Pediatric wide-field fundus photograph. 1440 x 1080 pixels
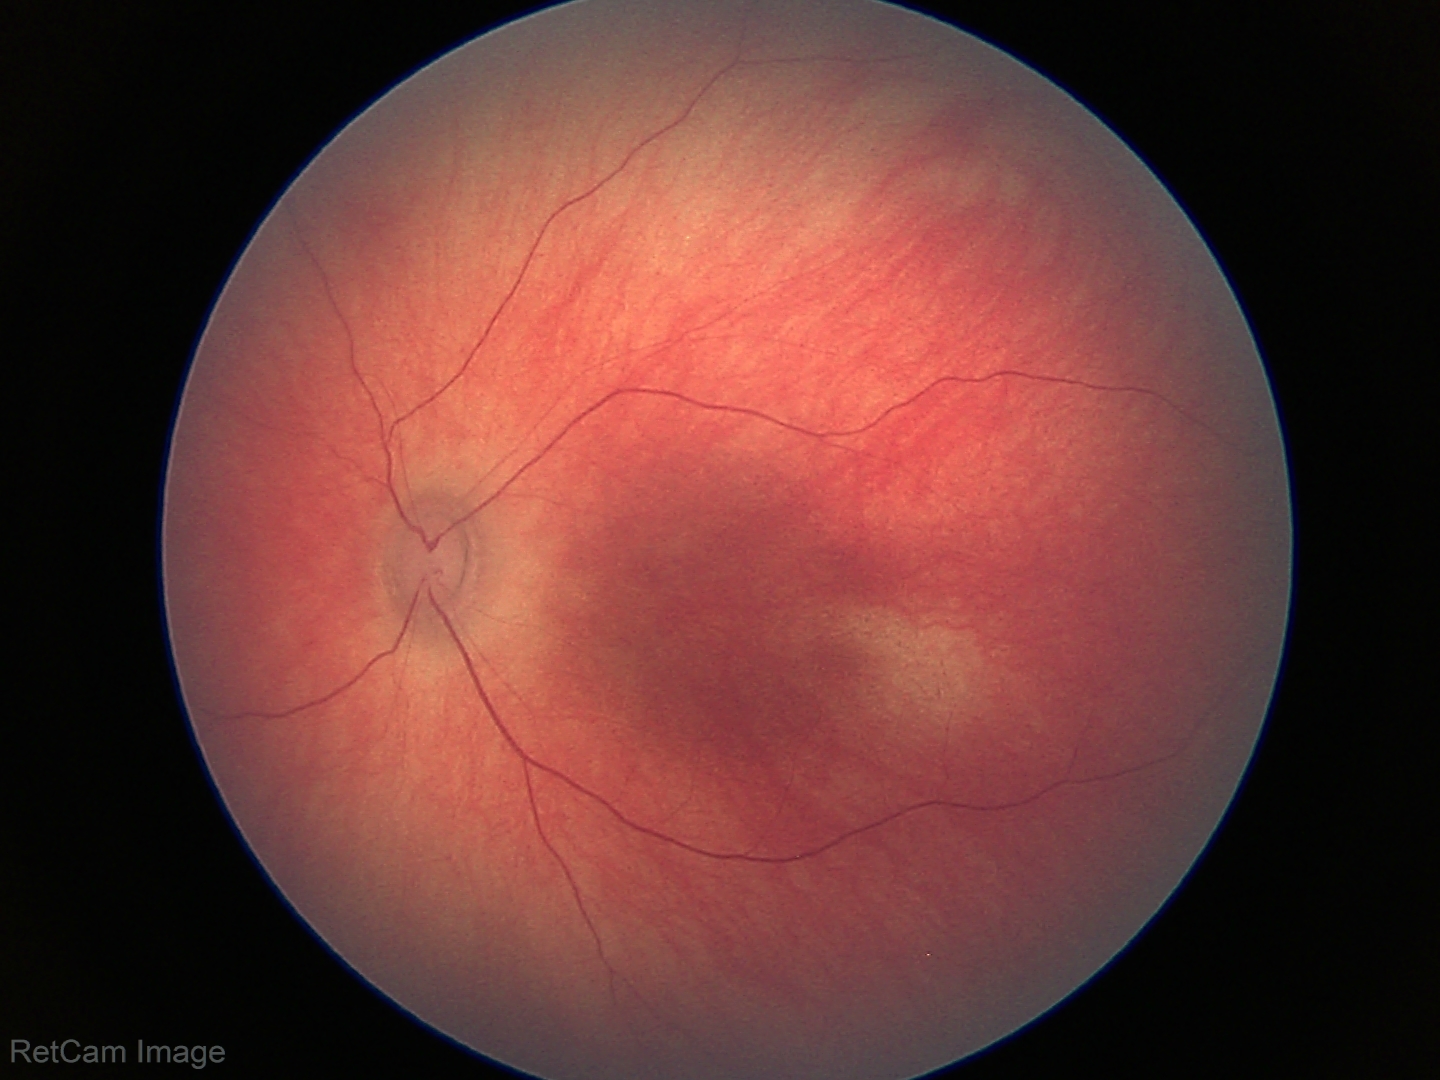 Physiological retinal appearance for postconceptual age.